1240x1240. Camera: Phoenix ICON (100° FOV). Wide-field fundus image from infant ROP screening — 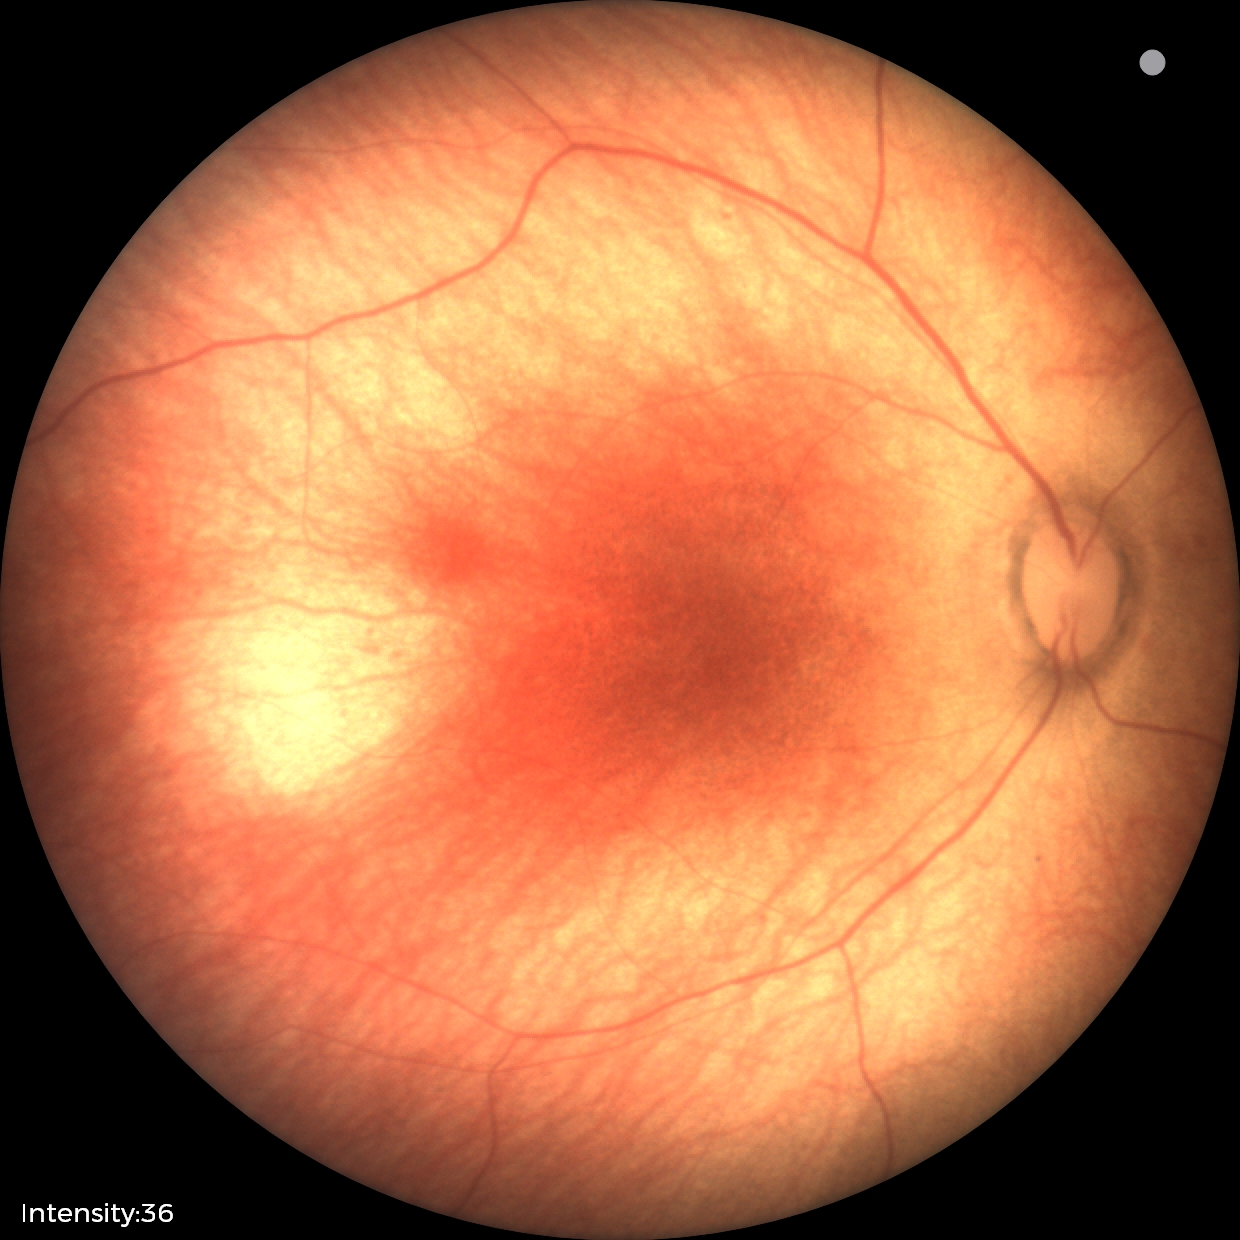

Physiological retinal appearance for postconceptual age.